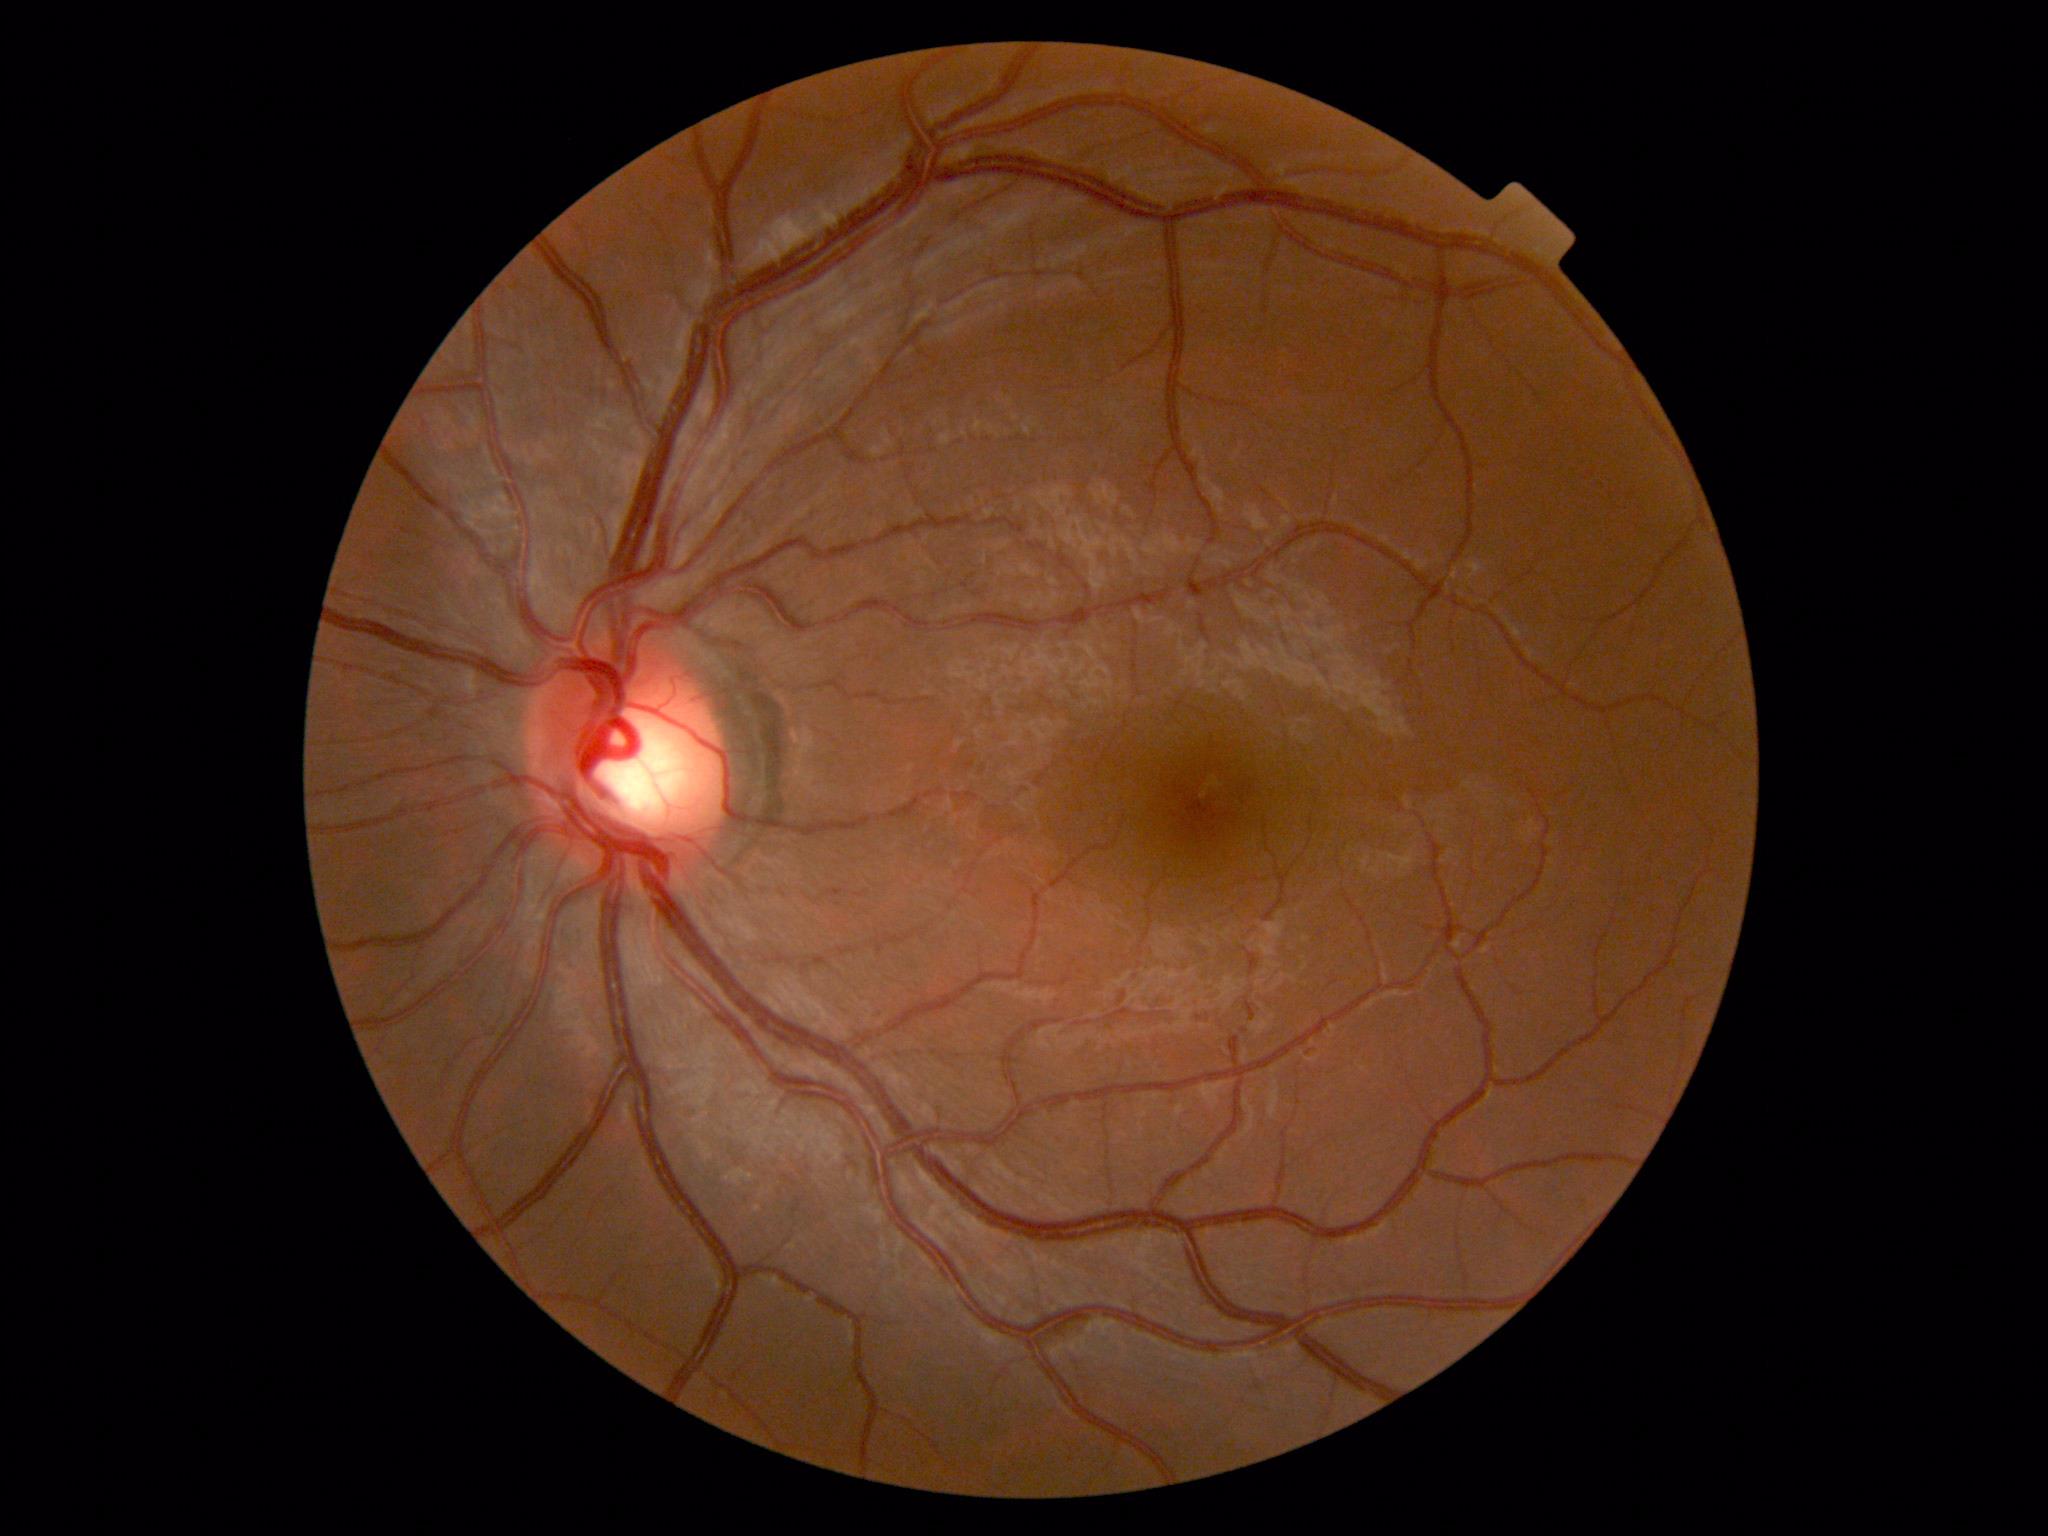

  dr_grade: grade 0 (no apparent retinopathy)
  dr_impression: no apparent DR